Fundus photo:
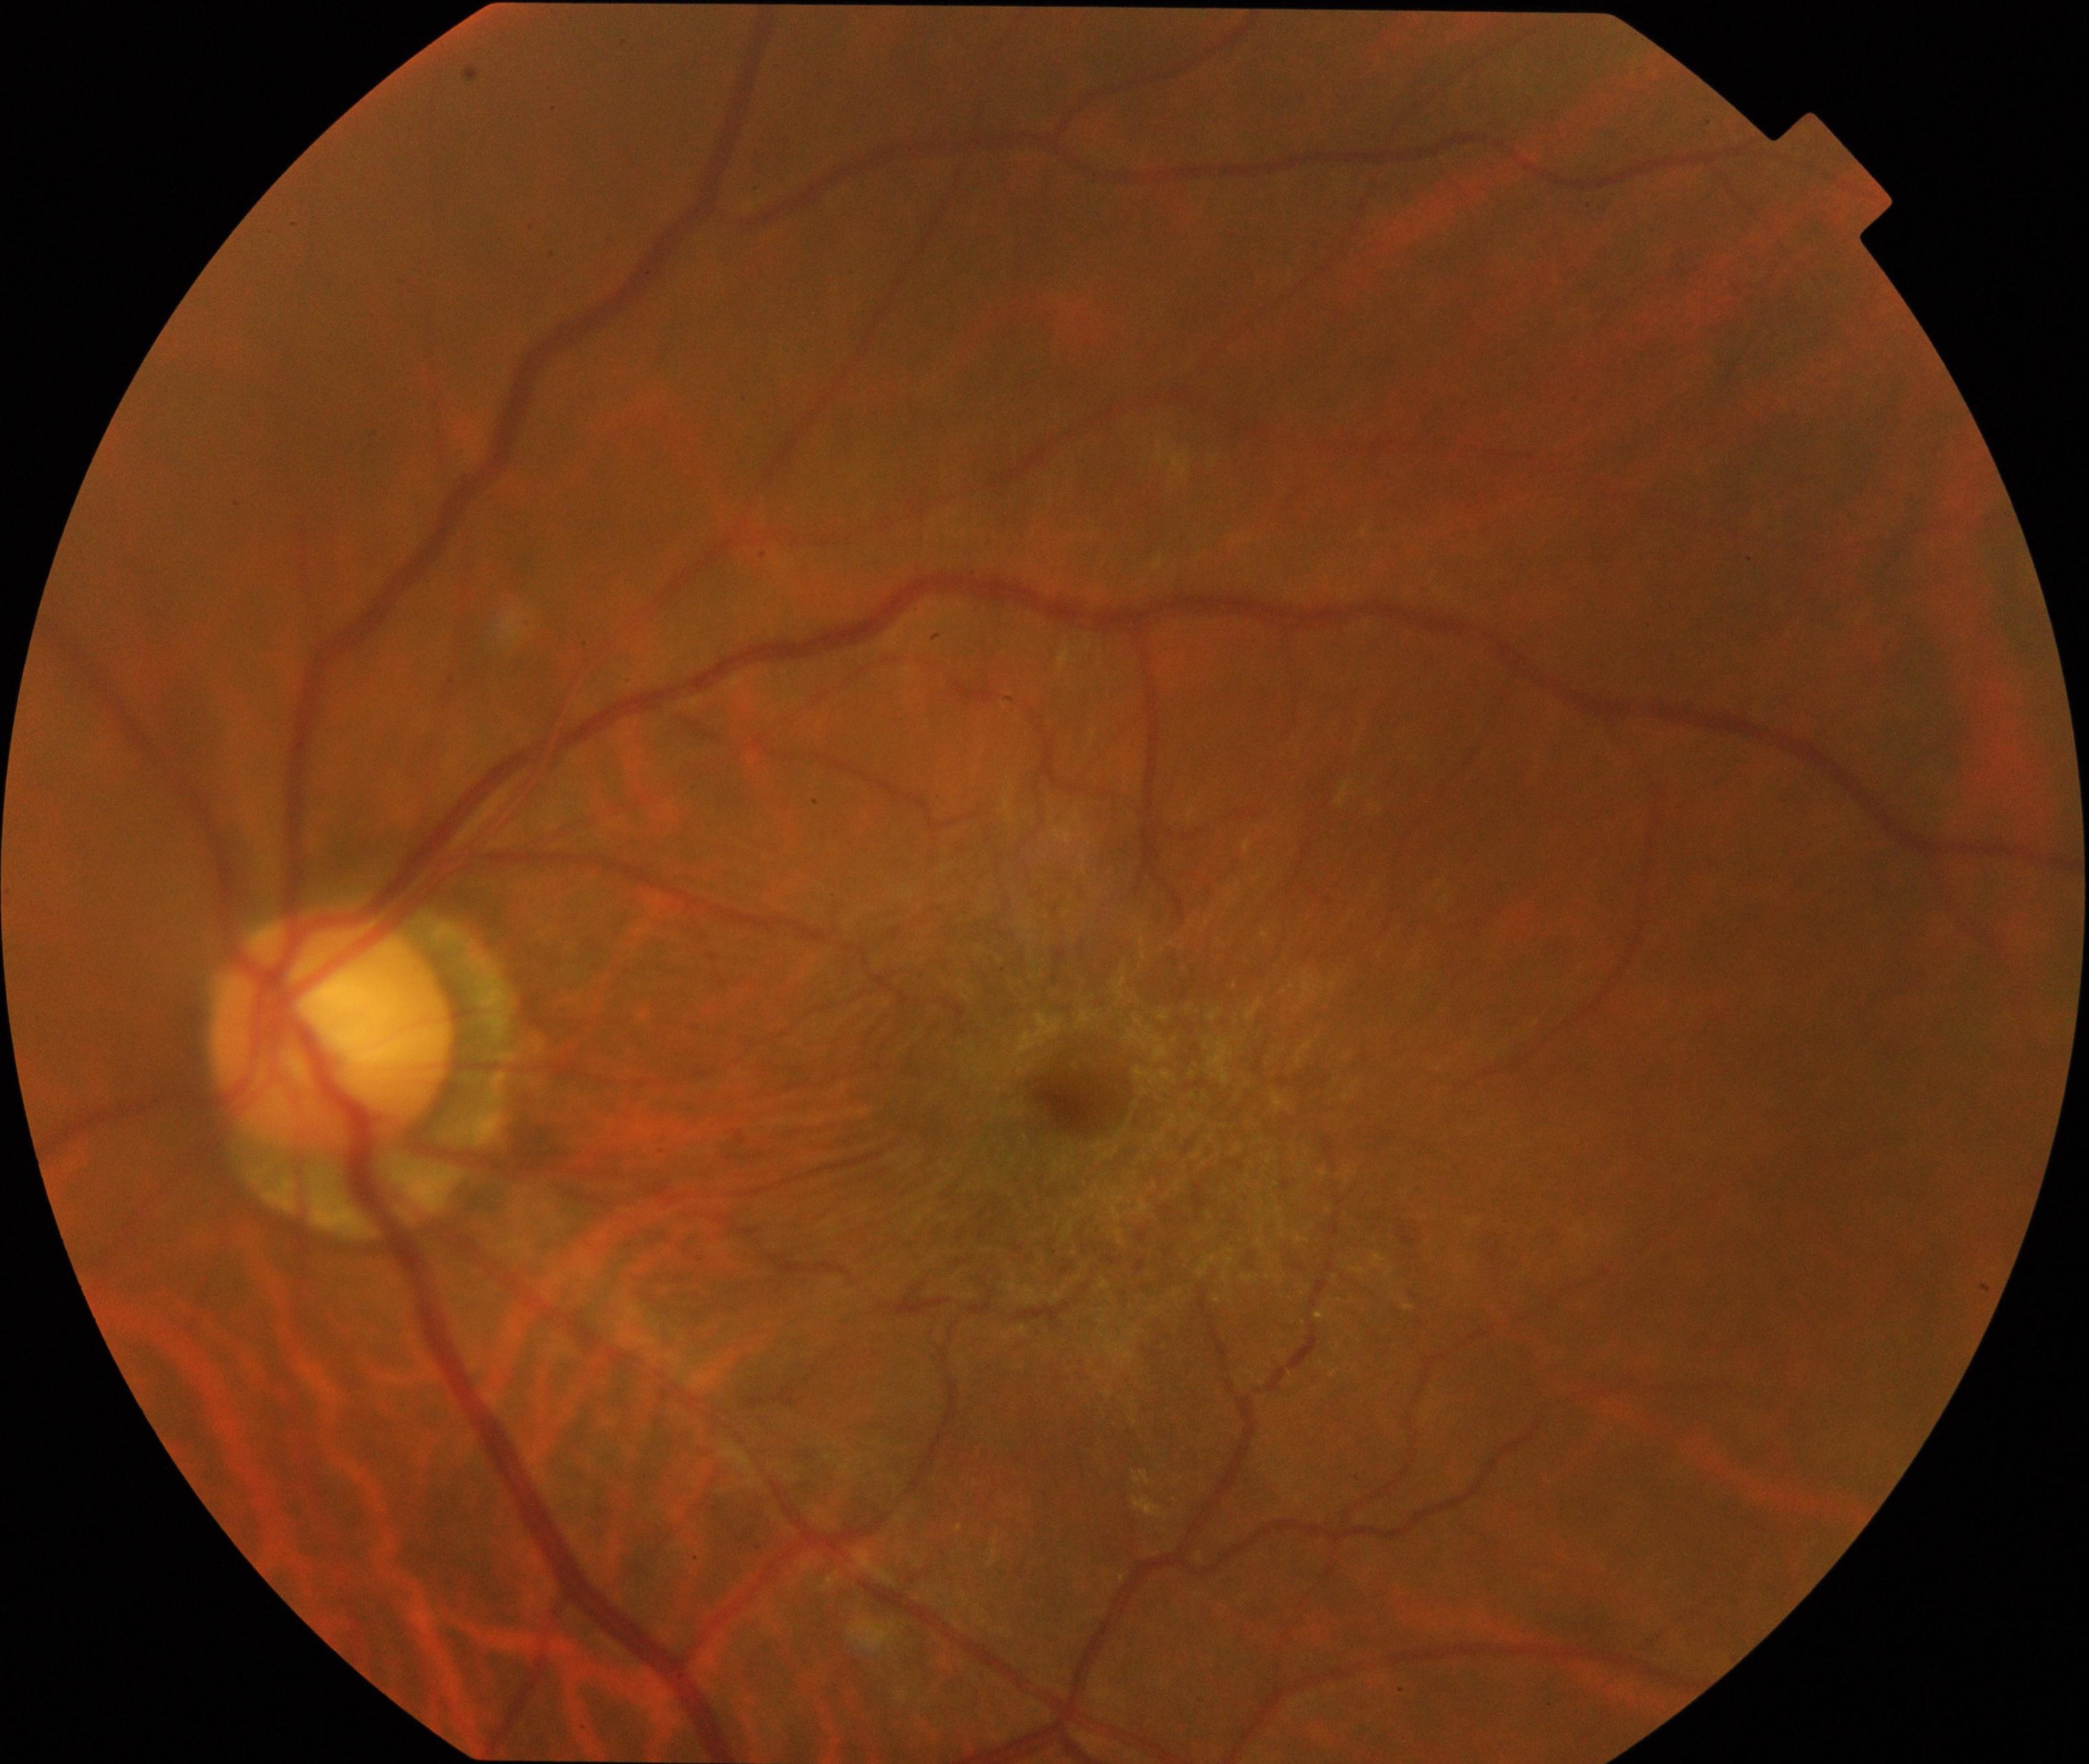
Diagnosis: epiretinal membrane (ERM).